45 degree fundus photograph · posterior pole photograph:
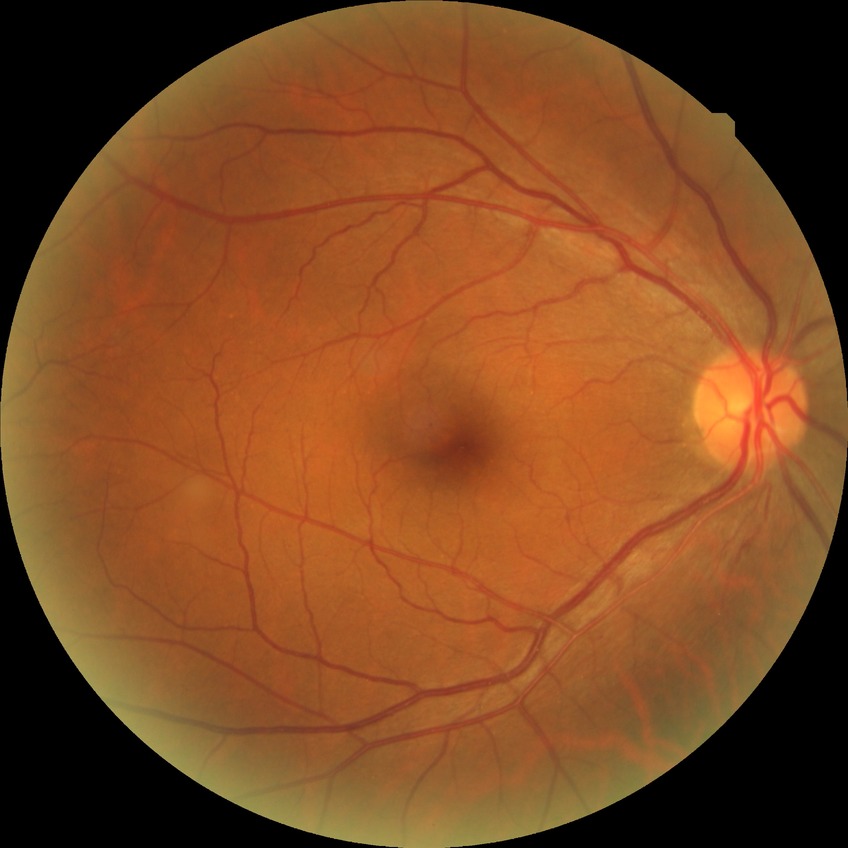

Diabetic retinopathy (DR): no diabetic retinopathy (NDR).